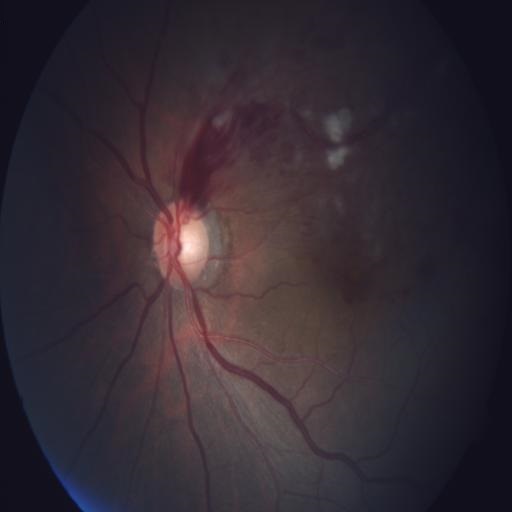 Findings consistent with branch retinal vein occlusion & cotton wool spots.